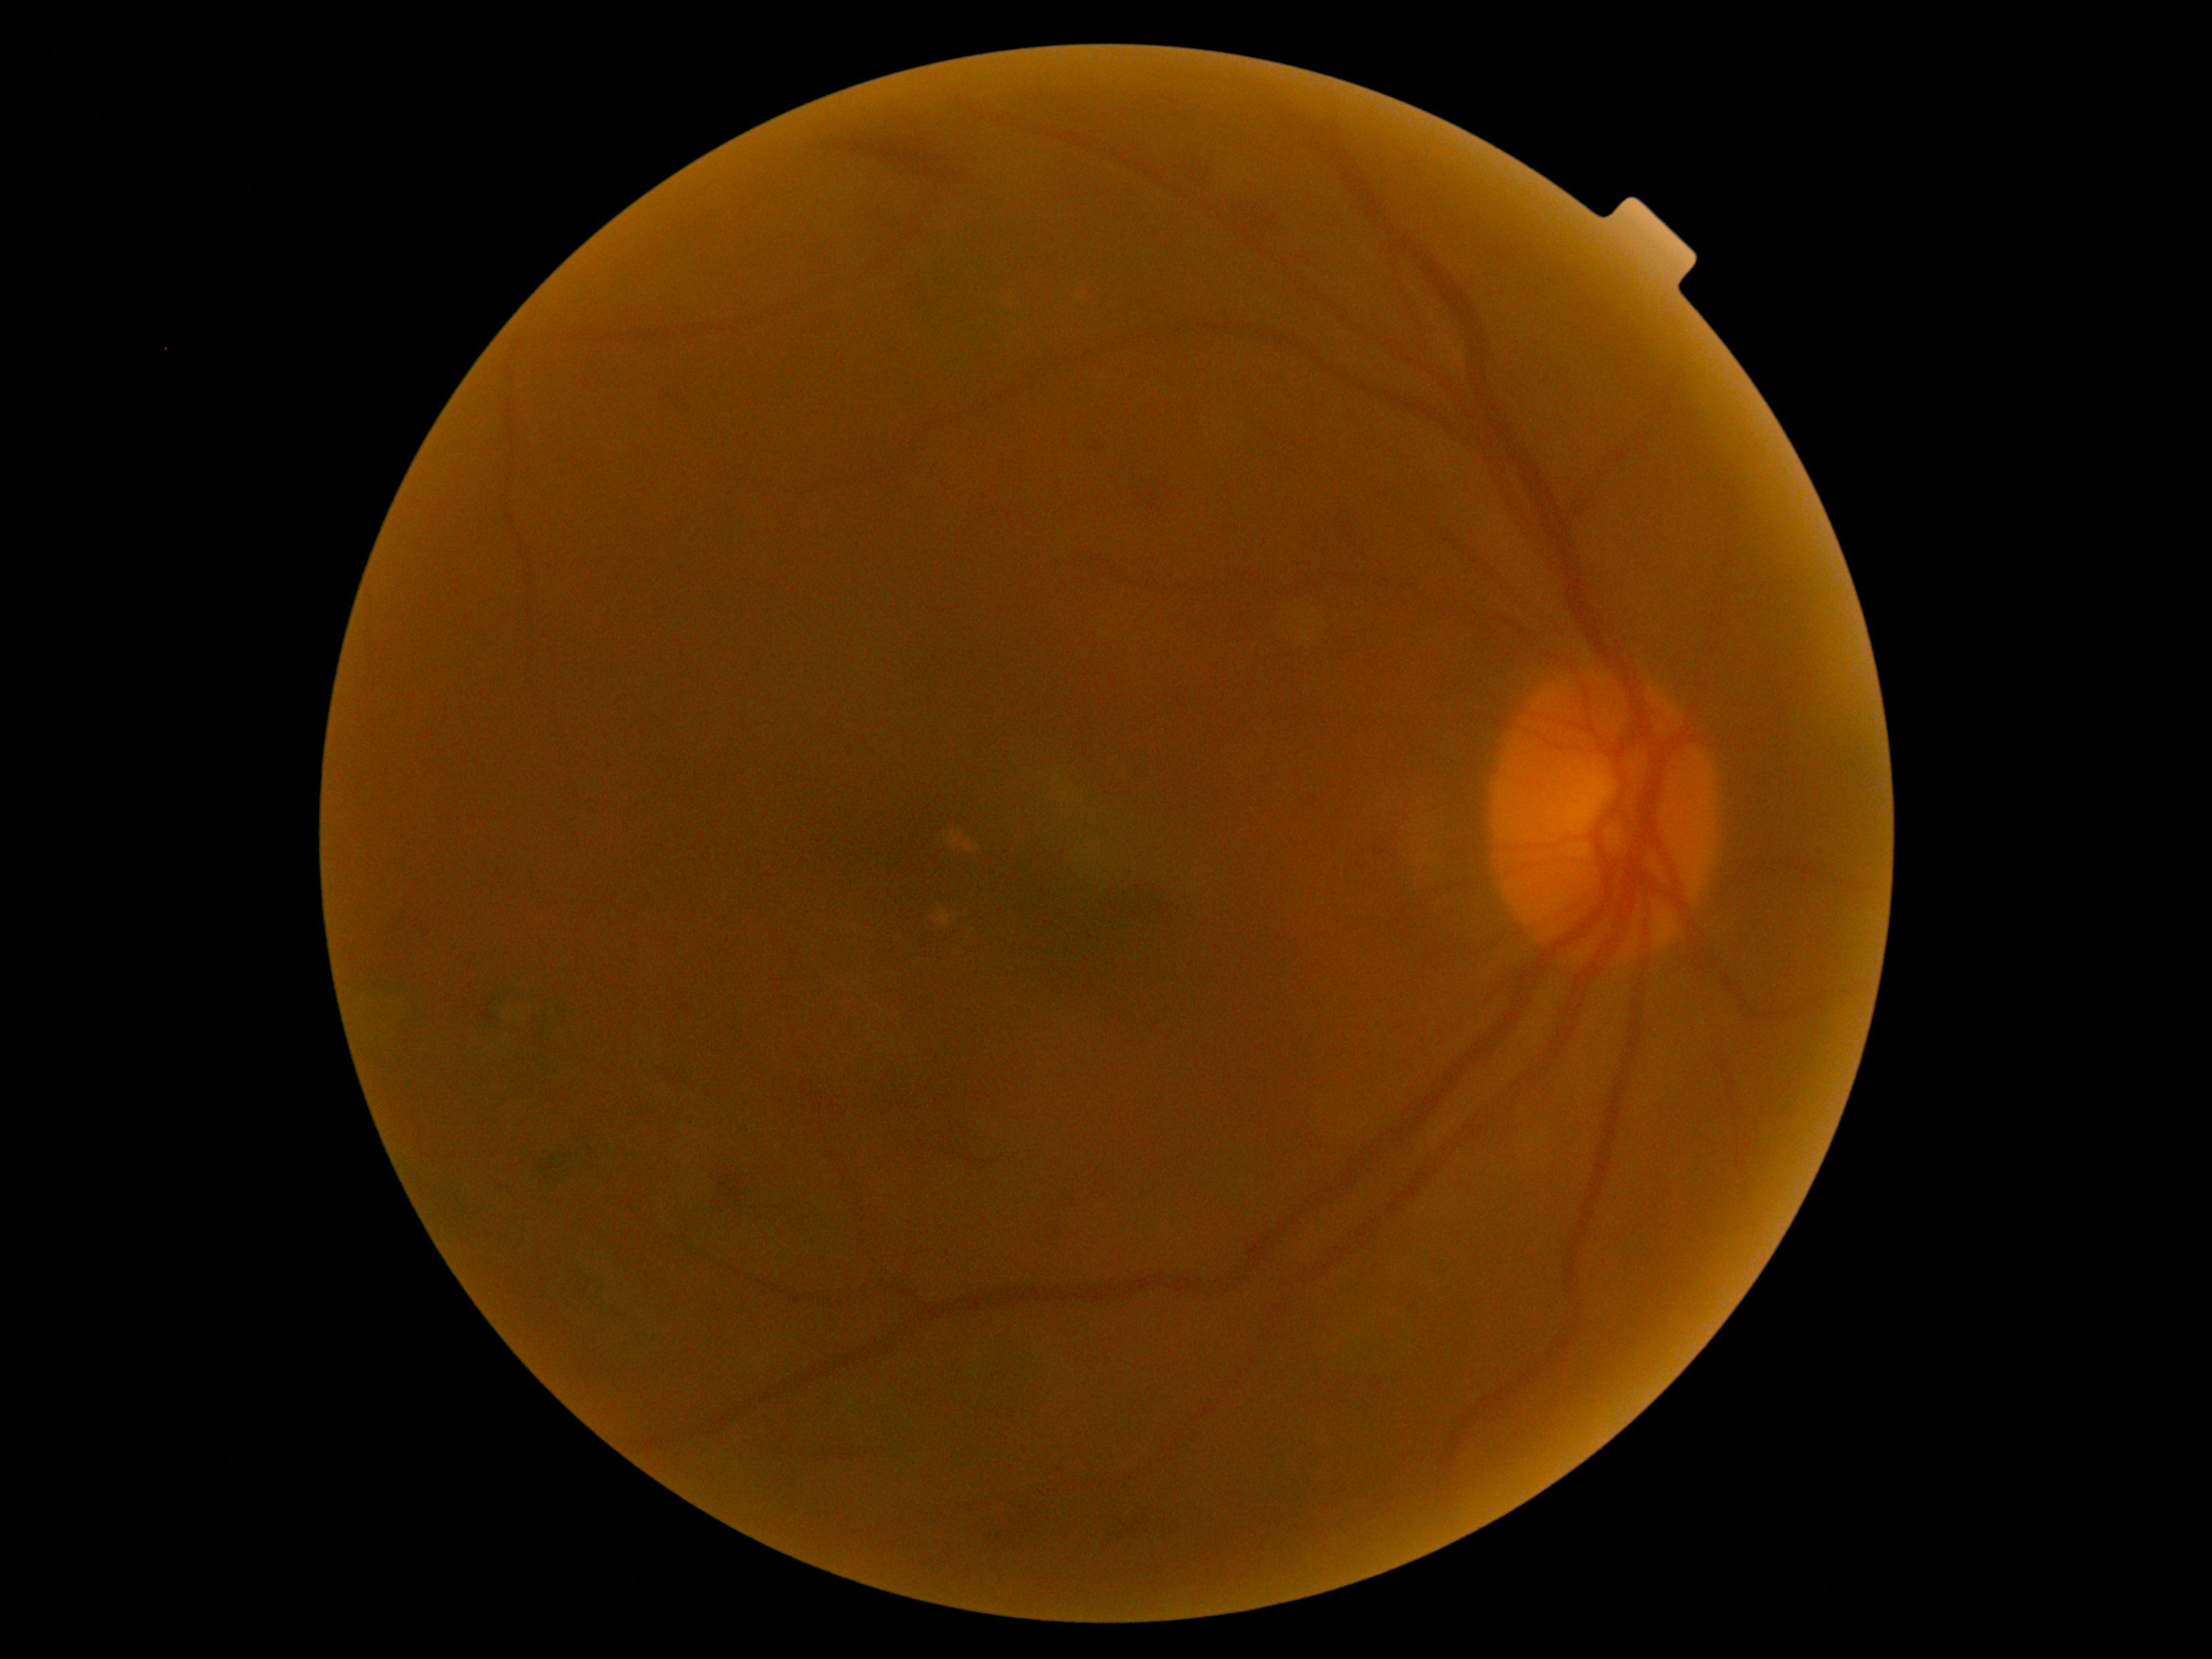

DR is 2/4.